Pediatric wide-field fundus photograph — 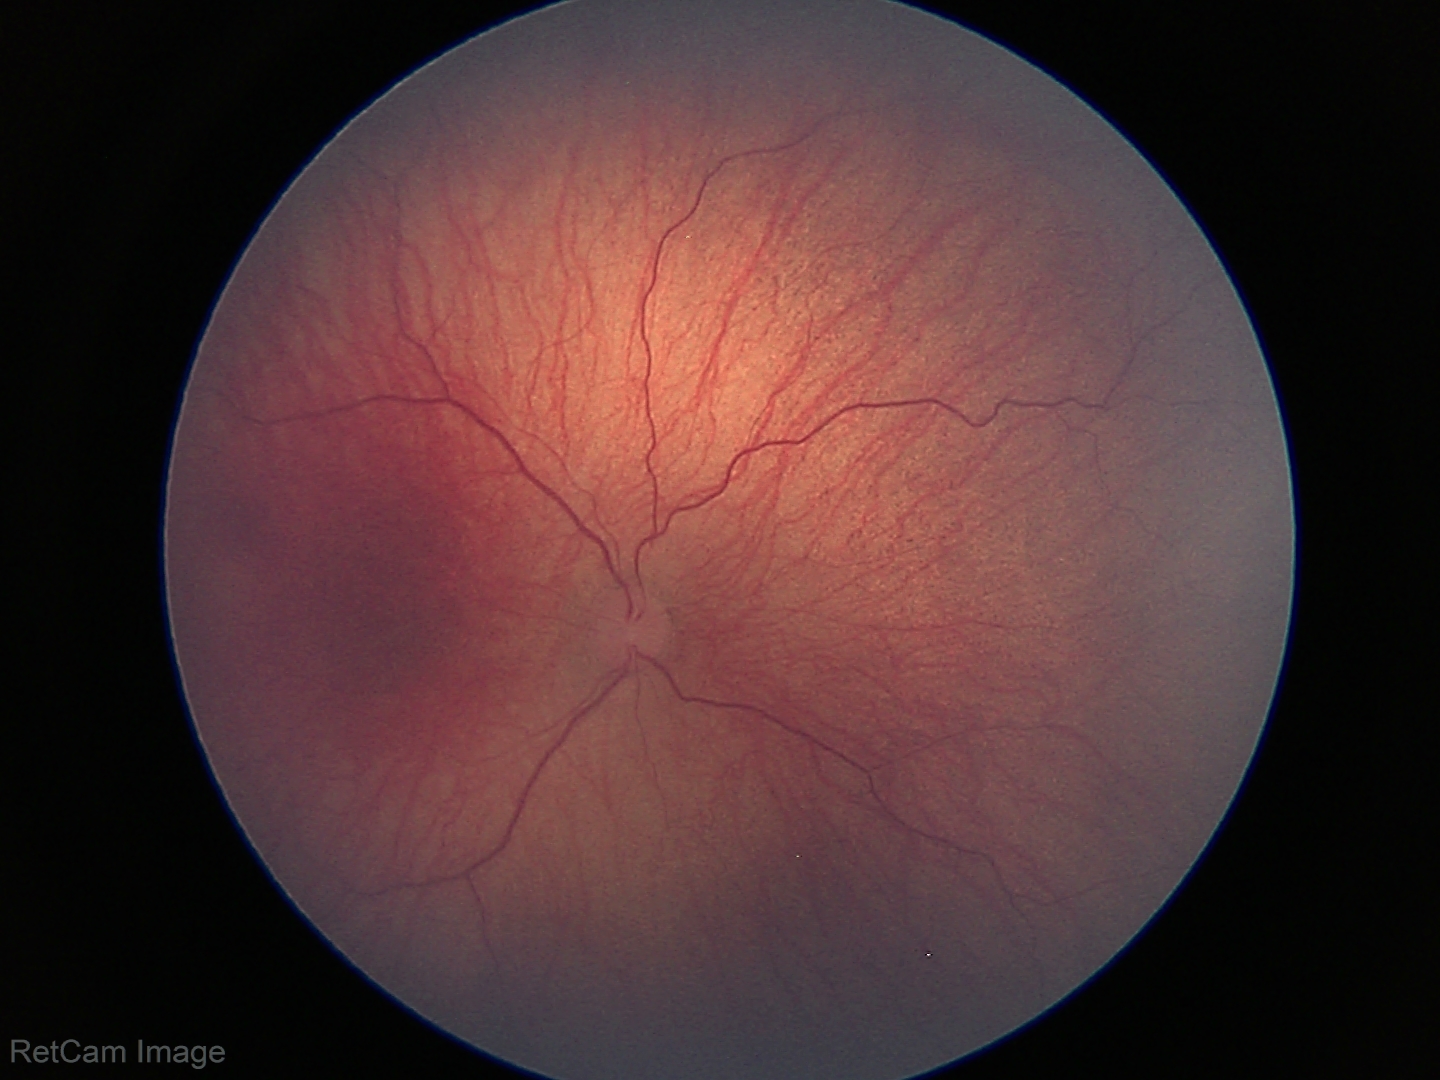

Plus disease: absent, diagnosis: retinopathy of prematurity (ROP) stage 1.